240 by 240 pixels. Color fundus photograph. Captured on a Nidek AFC-330 fundus camera:
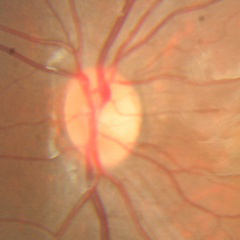
Optic disc appearance consistent with no glaucoma.